Fundus photo. 2352x1568
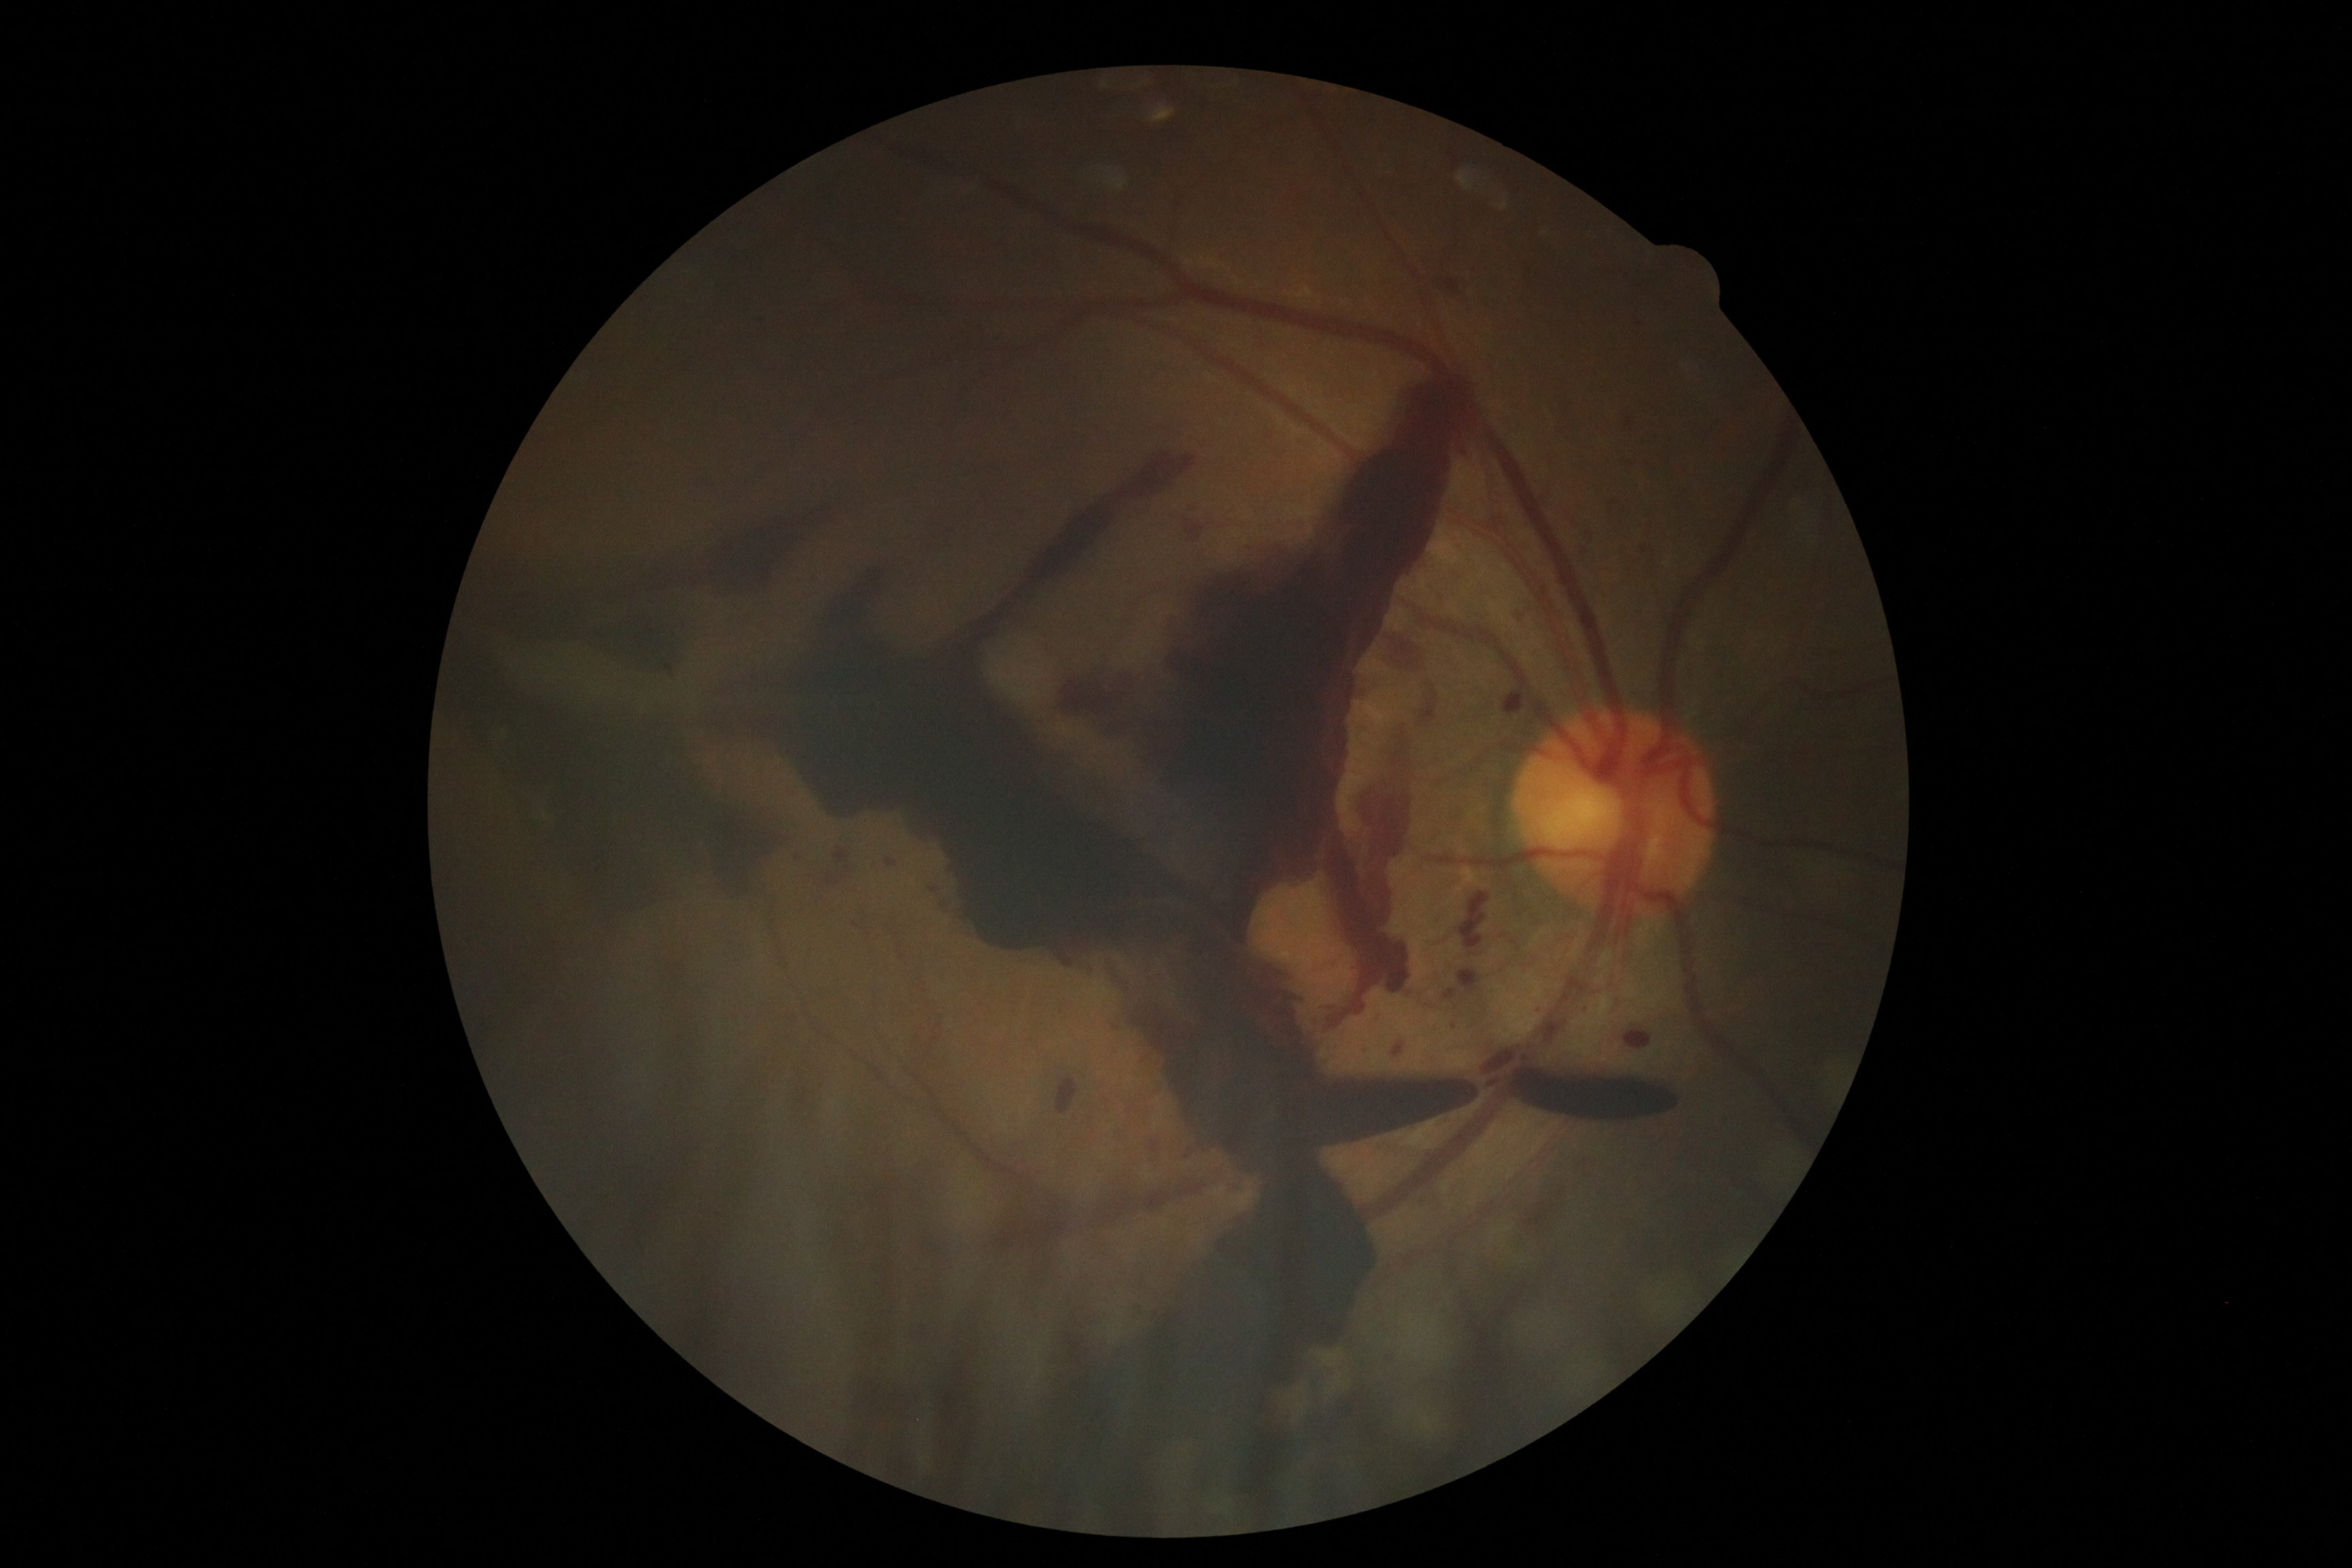 DR grade = PDR (4)